1240x1240px. Wide-field fundus photograph from neonatal ROP screening. Phoenix ICON, 100° FOV — 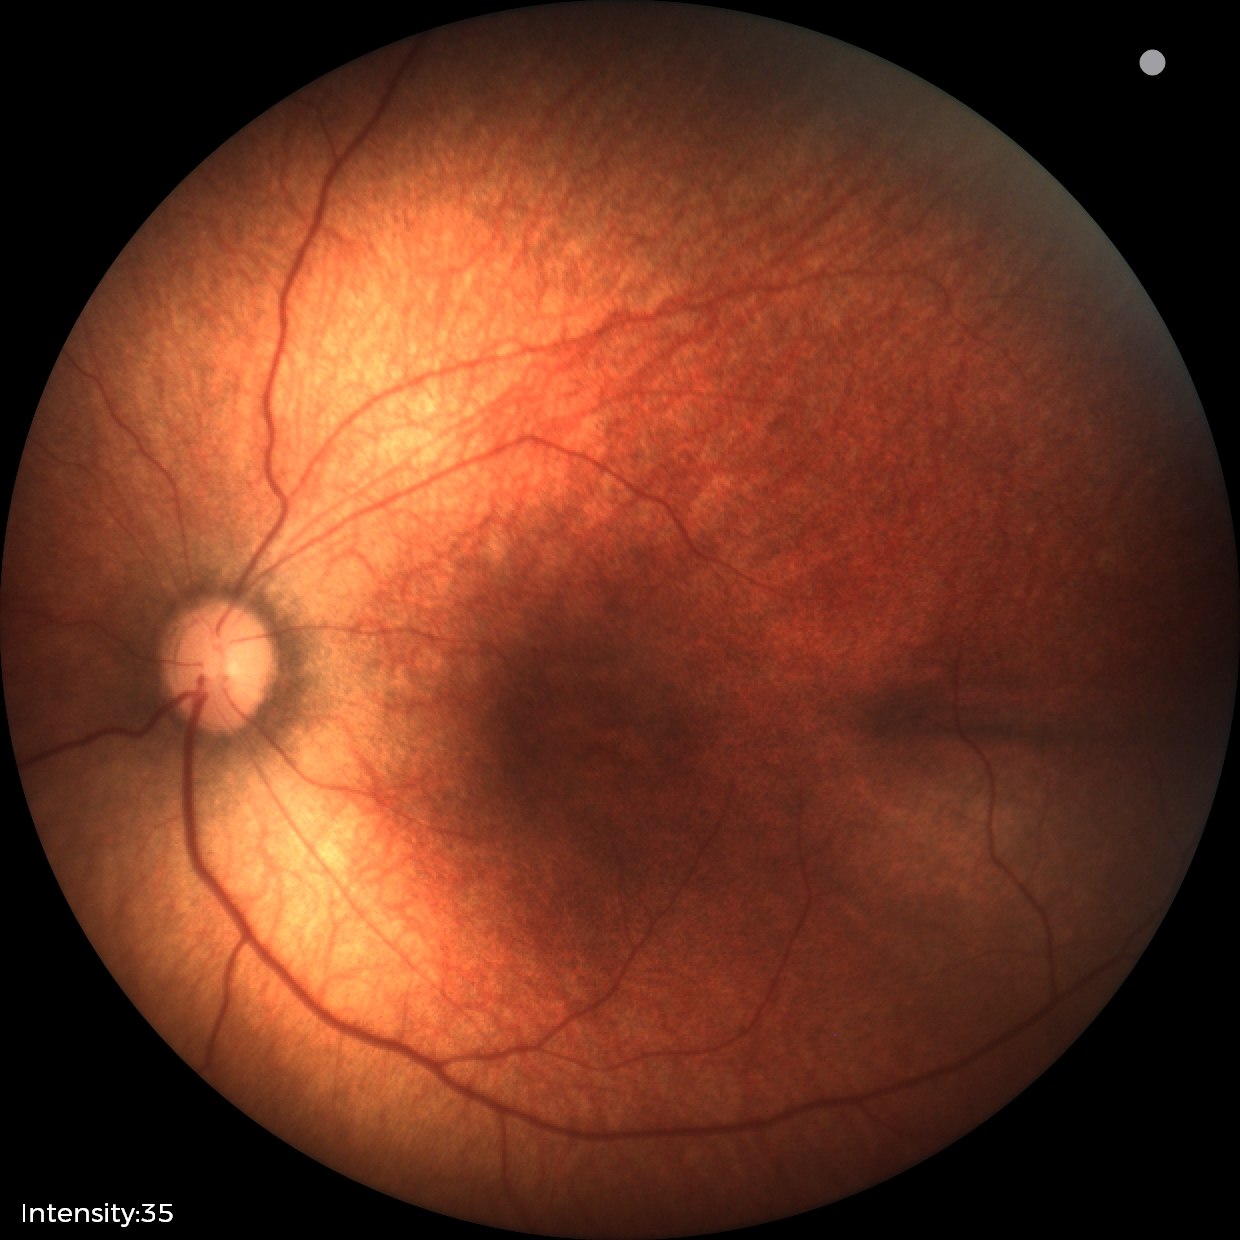

Normal screening examination.